Portable fundus camera image, 2212 x 1659 pixels:
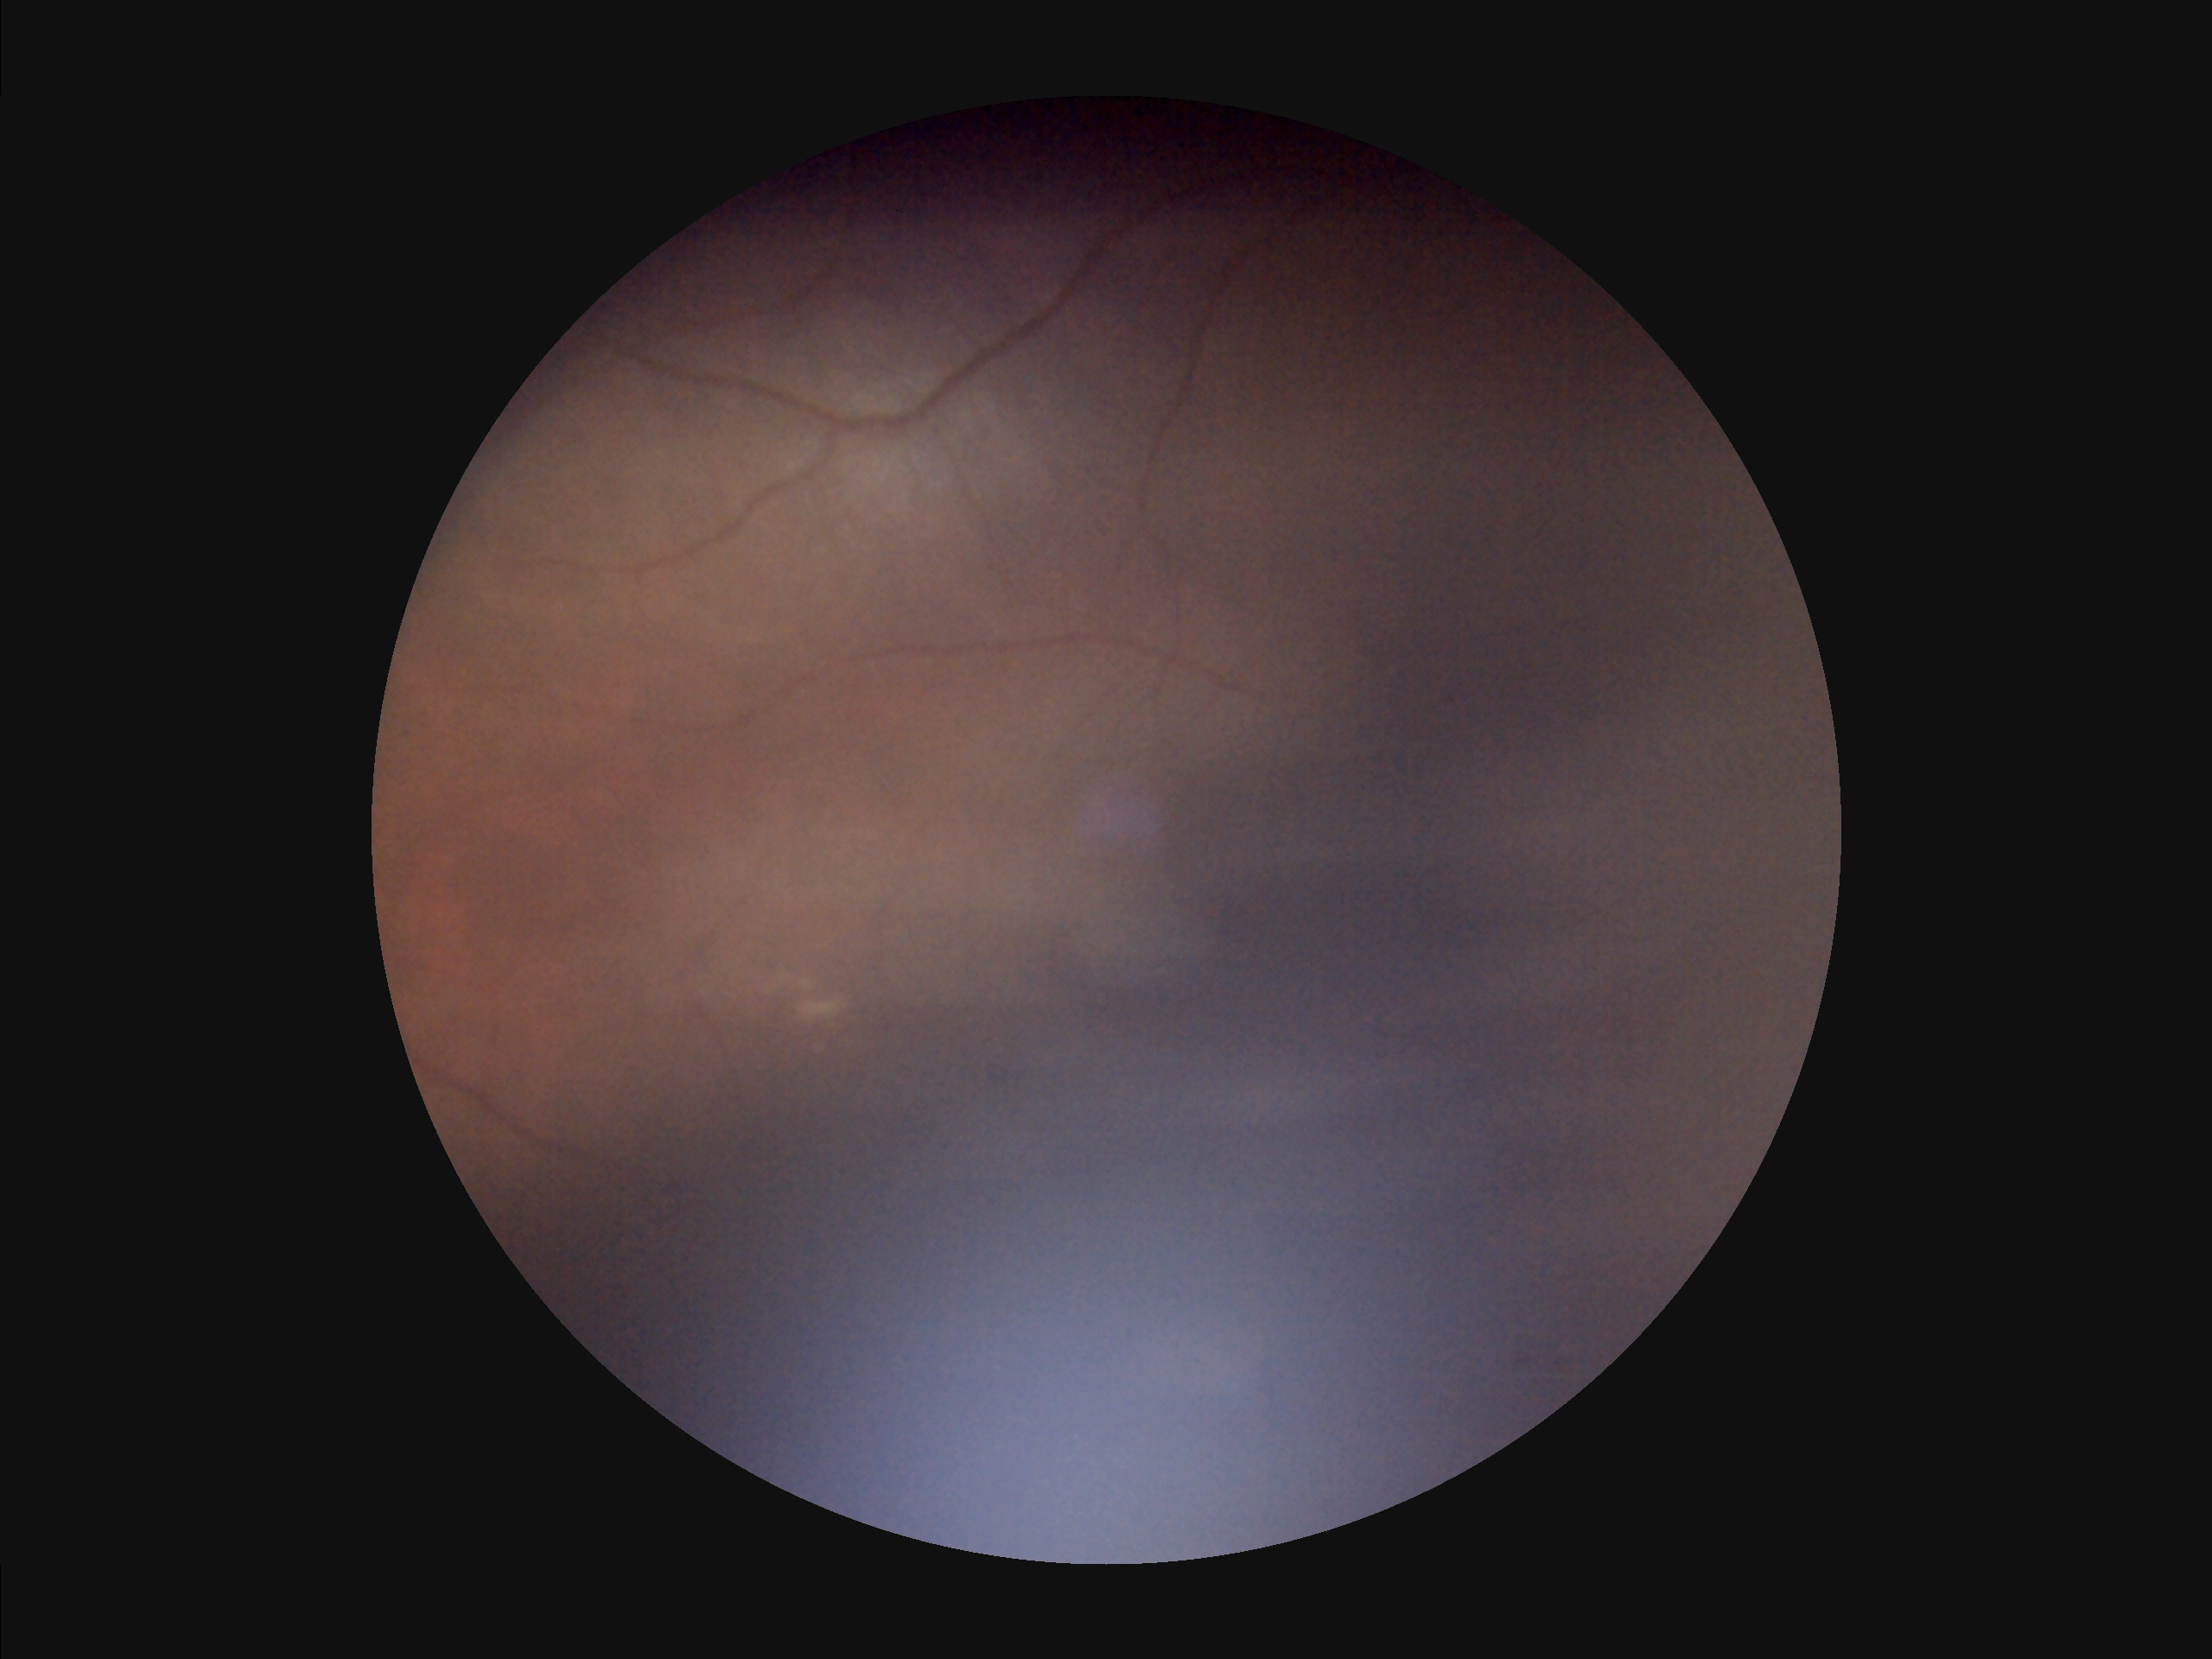 Poor illumination with uneven exposure.
Image quality is inadequate for diagnostic use.
Reduced sharpness with visible blur.
Vessels and details are hard to distinguish.